2352x1568px. Fundus photo.
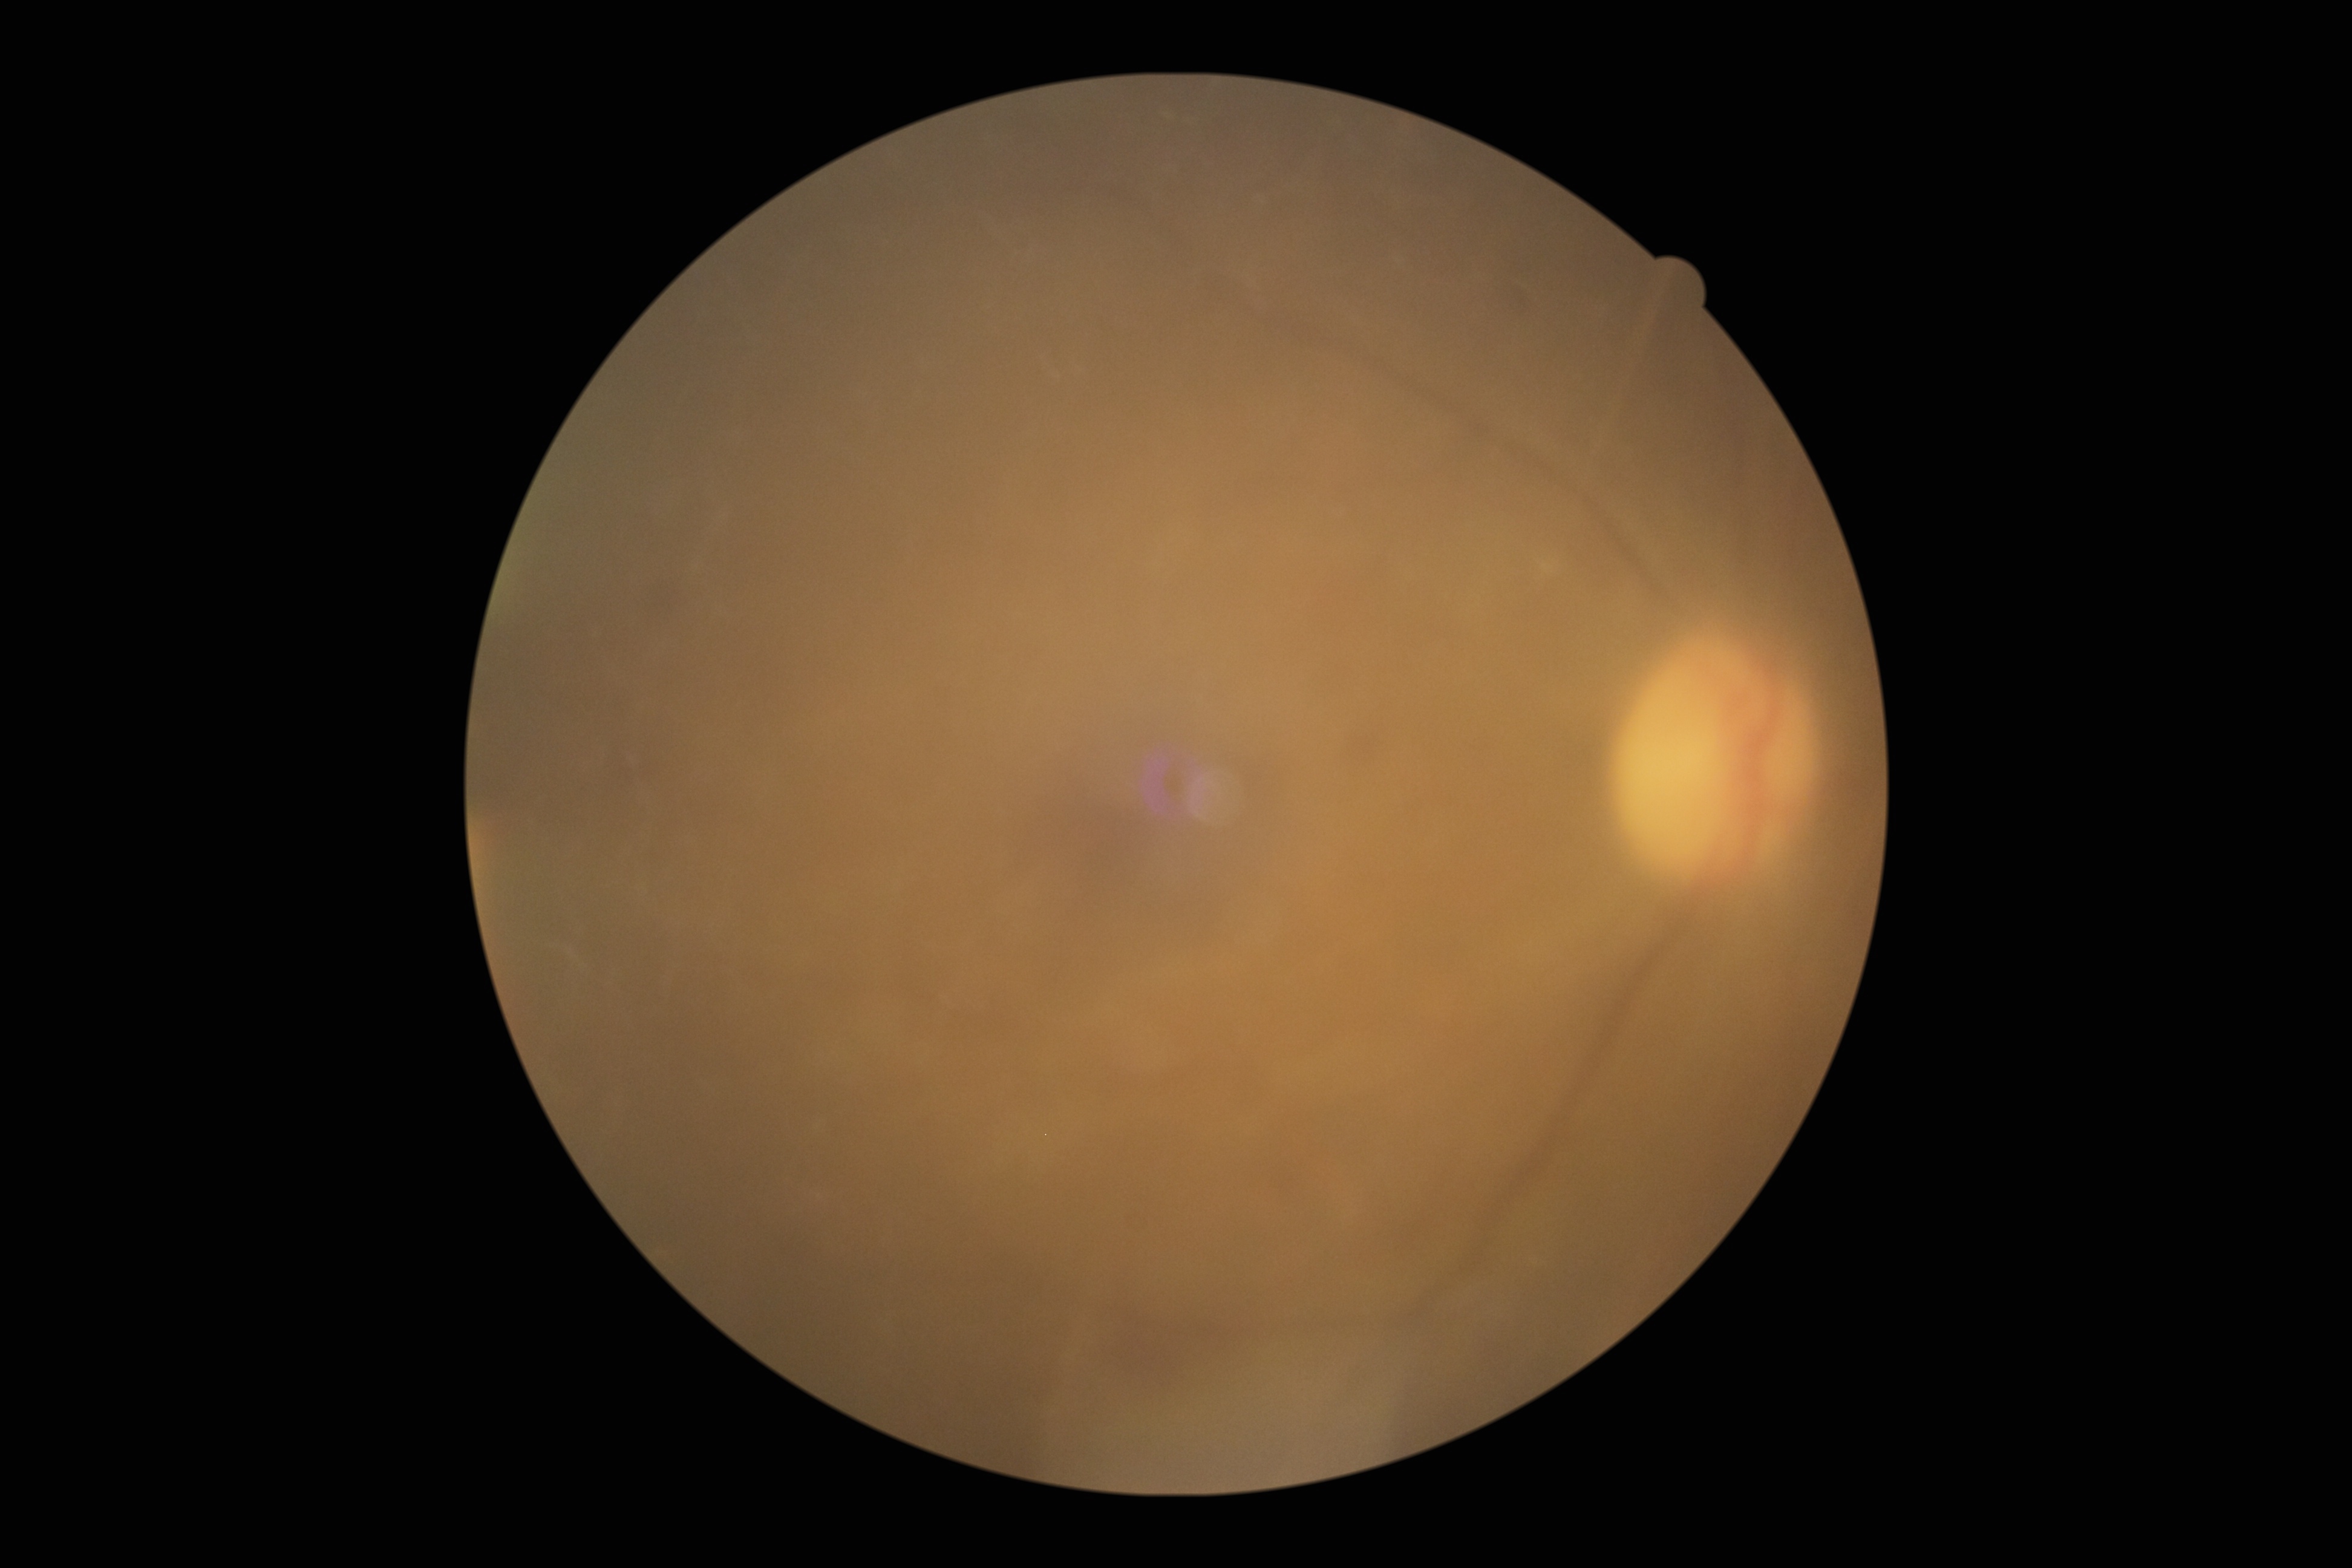 The image cannot be graded for diabetic retinopathy. DR is ungradable.